Acquired with a Remidio smartphone fundus camera:
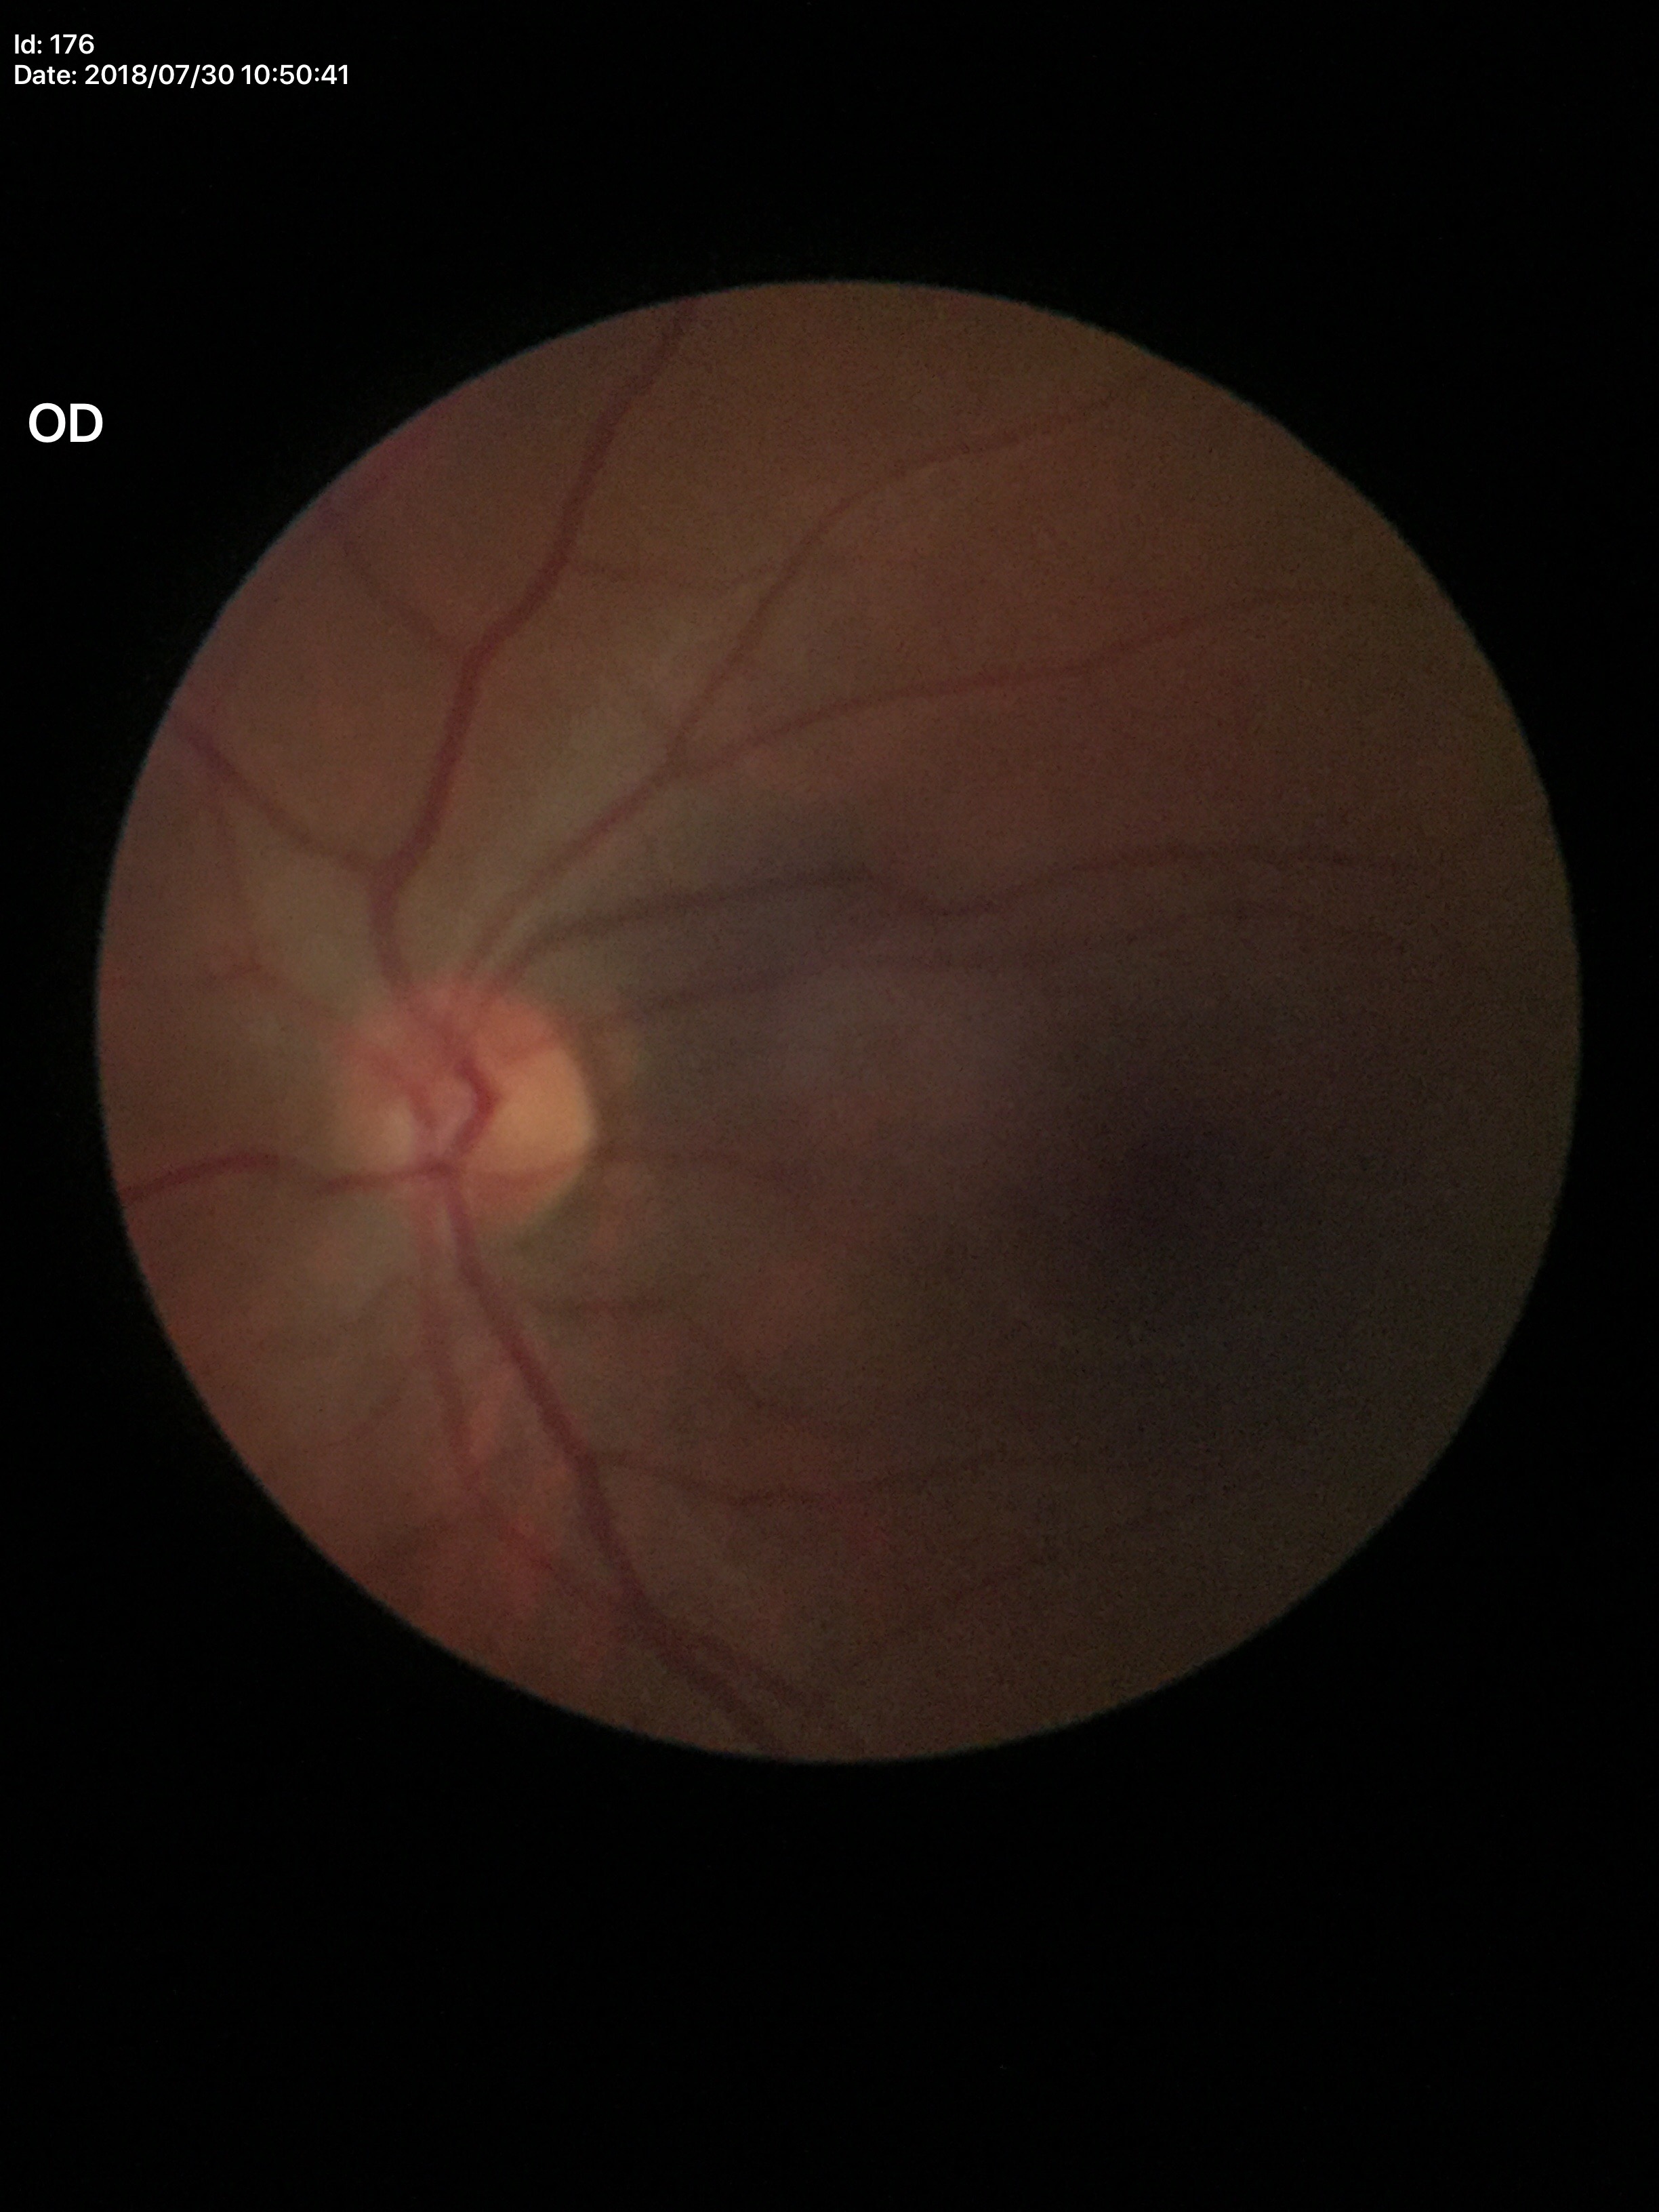 {"hcdr": "0.56", "vcdr": "0.50", "glaucoma_decision": "negative"}